Color fundus image. FOV: 45 degrees. NIDEK AFC-230: 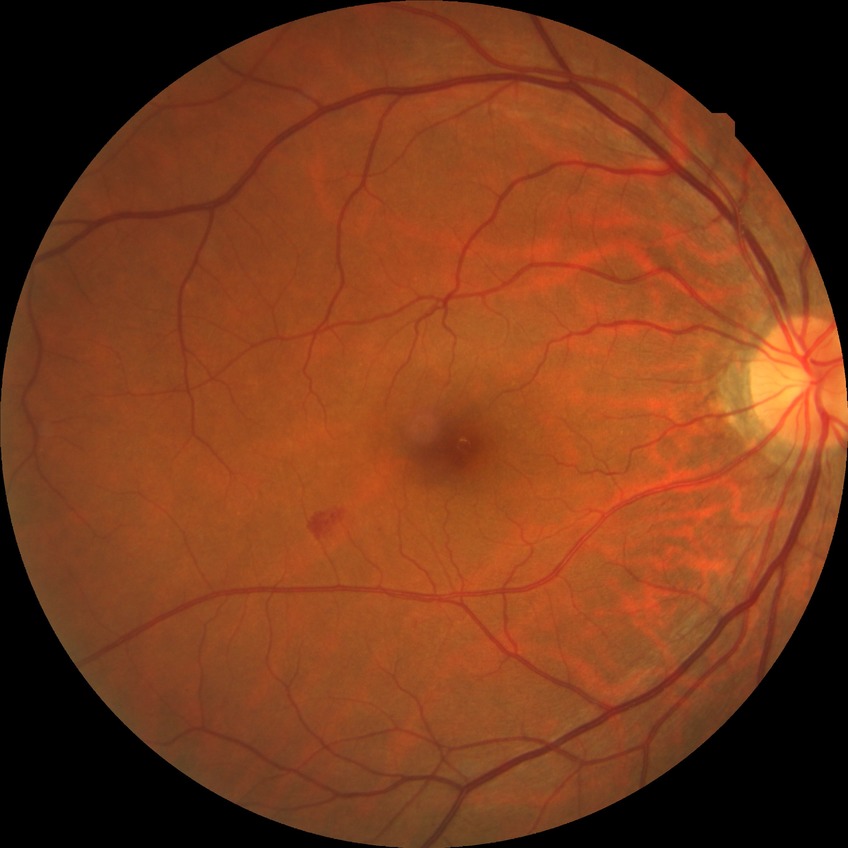
diabetic retinopathy (DR): simple diabetic retinopathy (SDR).